50° field of view. Field includes the optic disc and macula. CFP. Mydriatic (tropicamide and phenylephrine). Camera: Topcon TRC-50DX. 2228x1652px
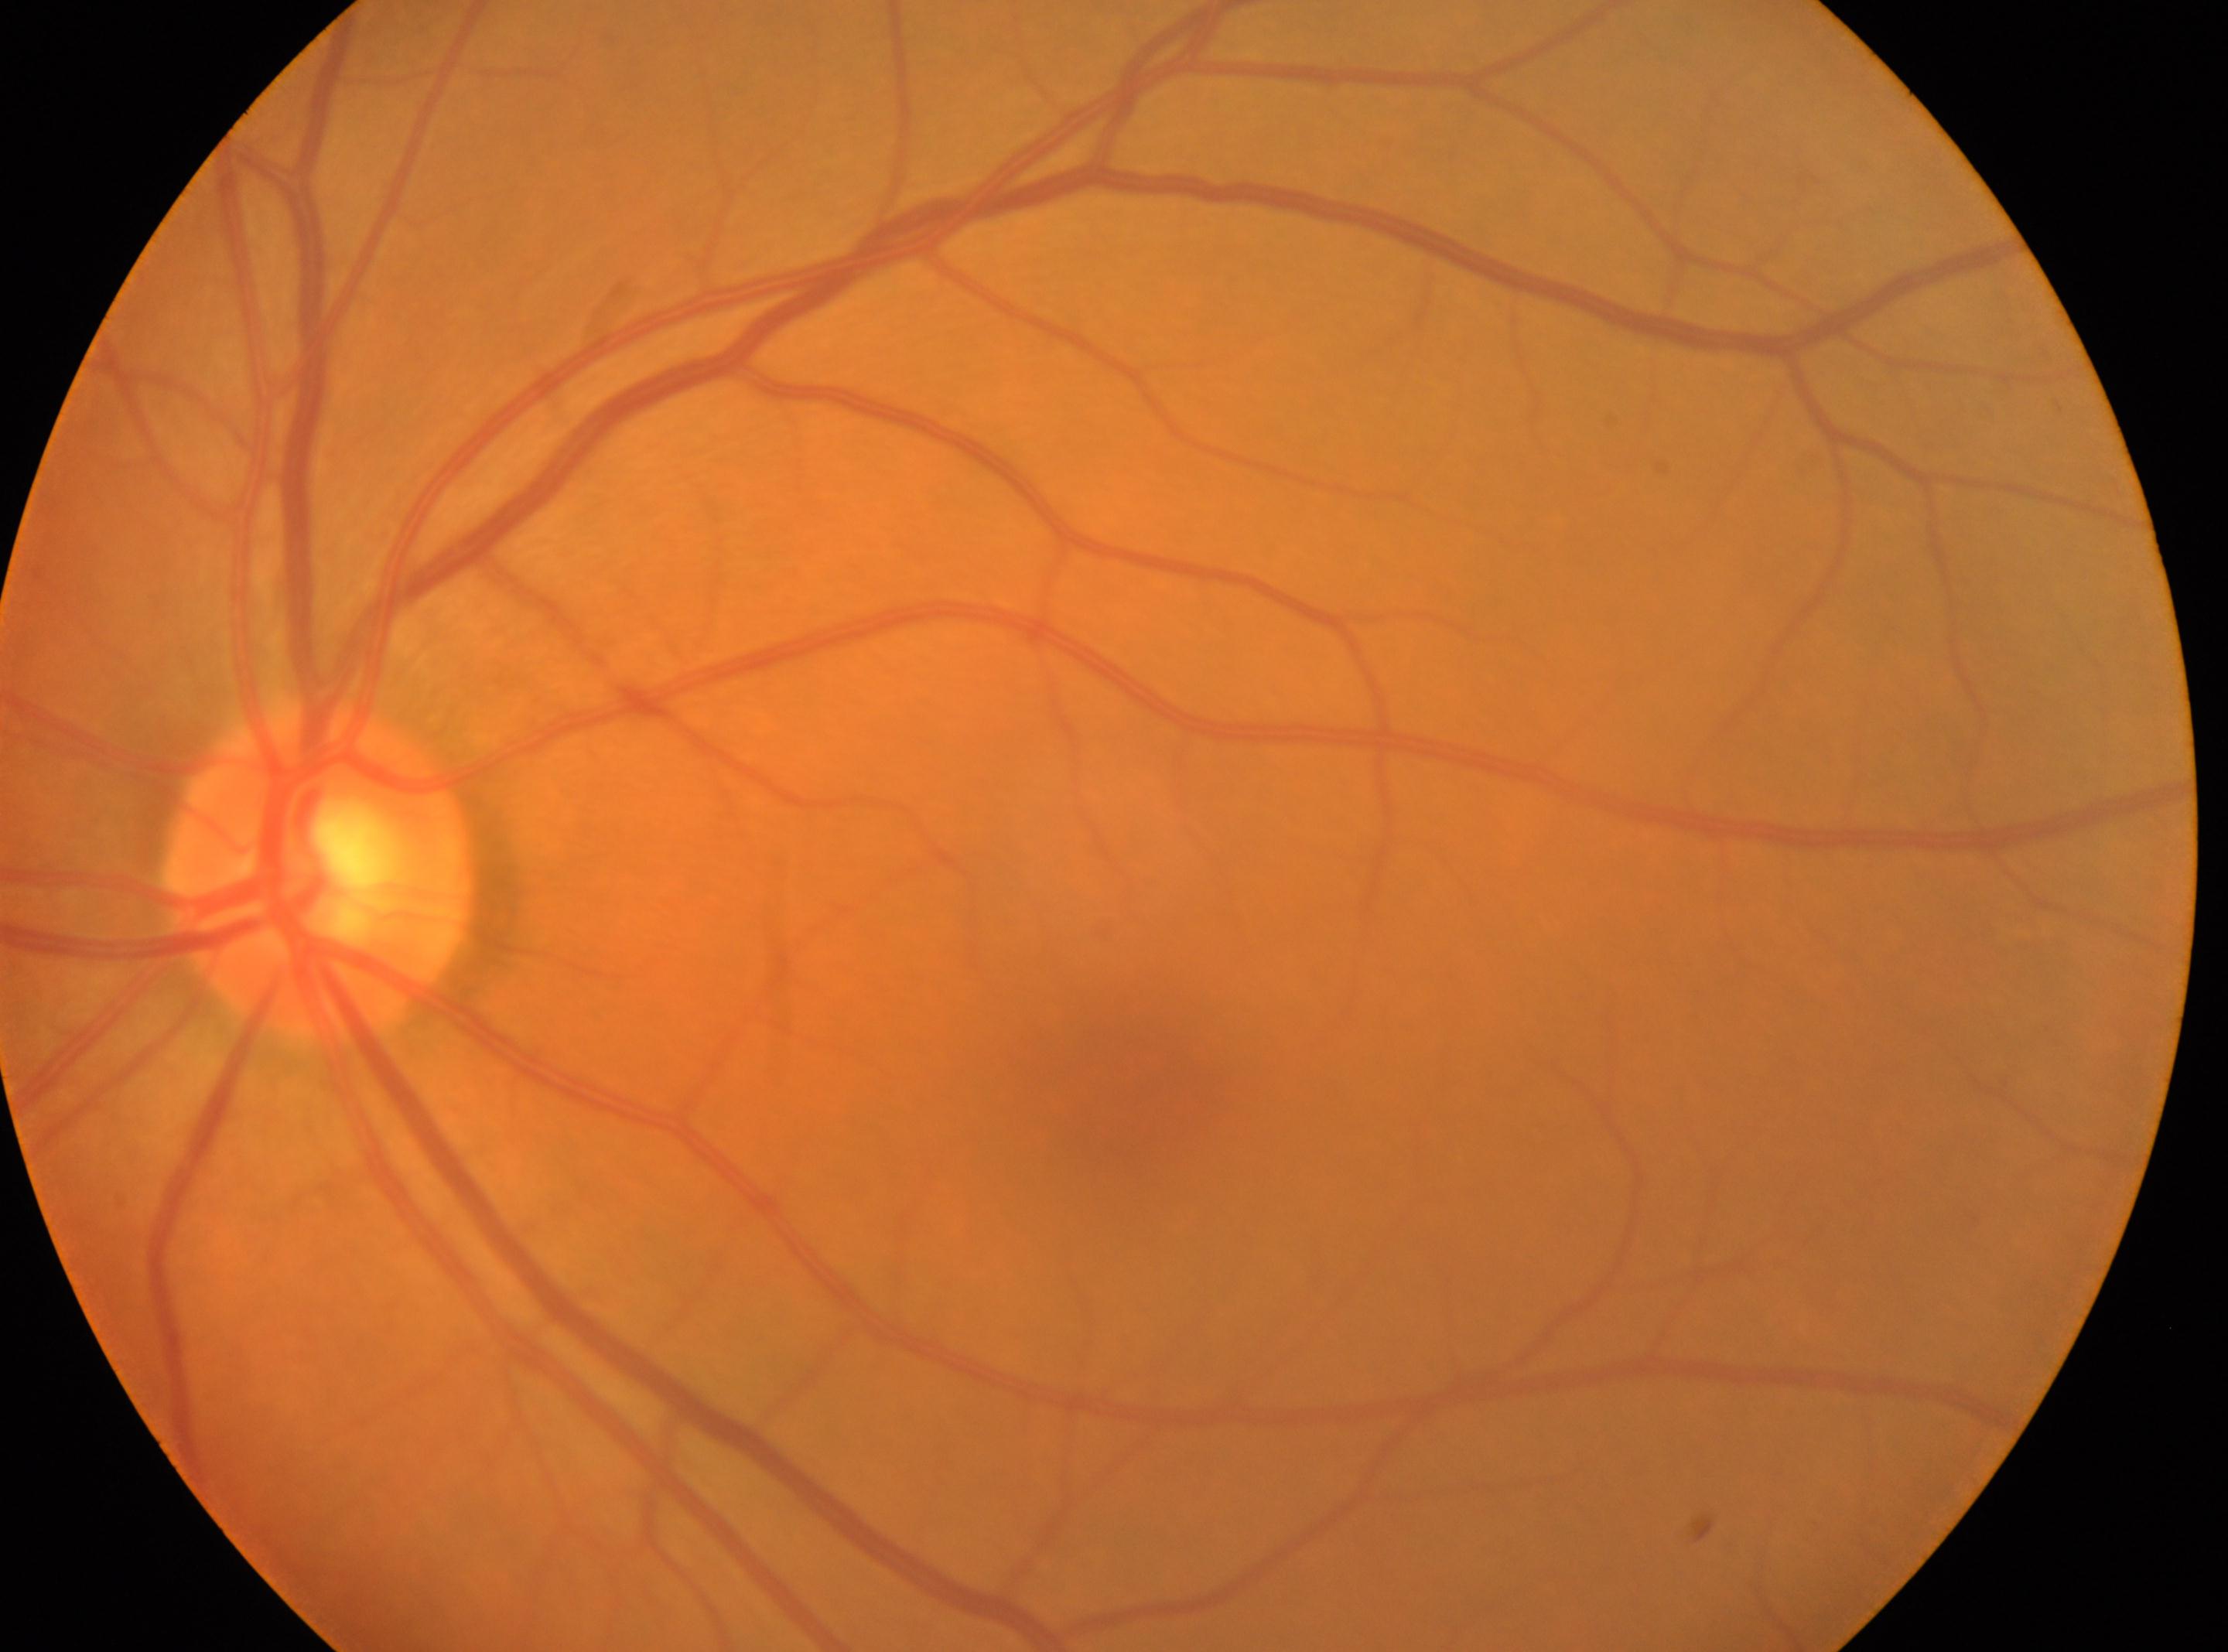

DR grade: 0 (no apparent retinopathy). The fovea is at 1133px, 1100px. The optic disk is at 318px, 871px. Imaged eye: OS.